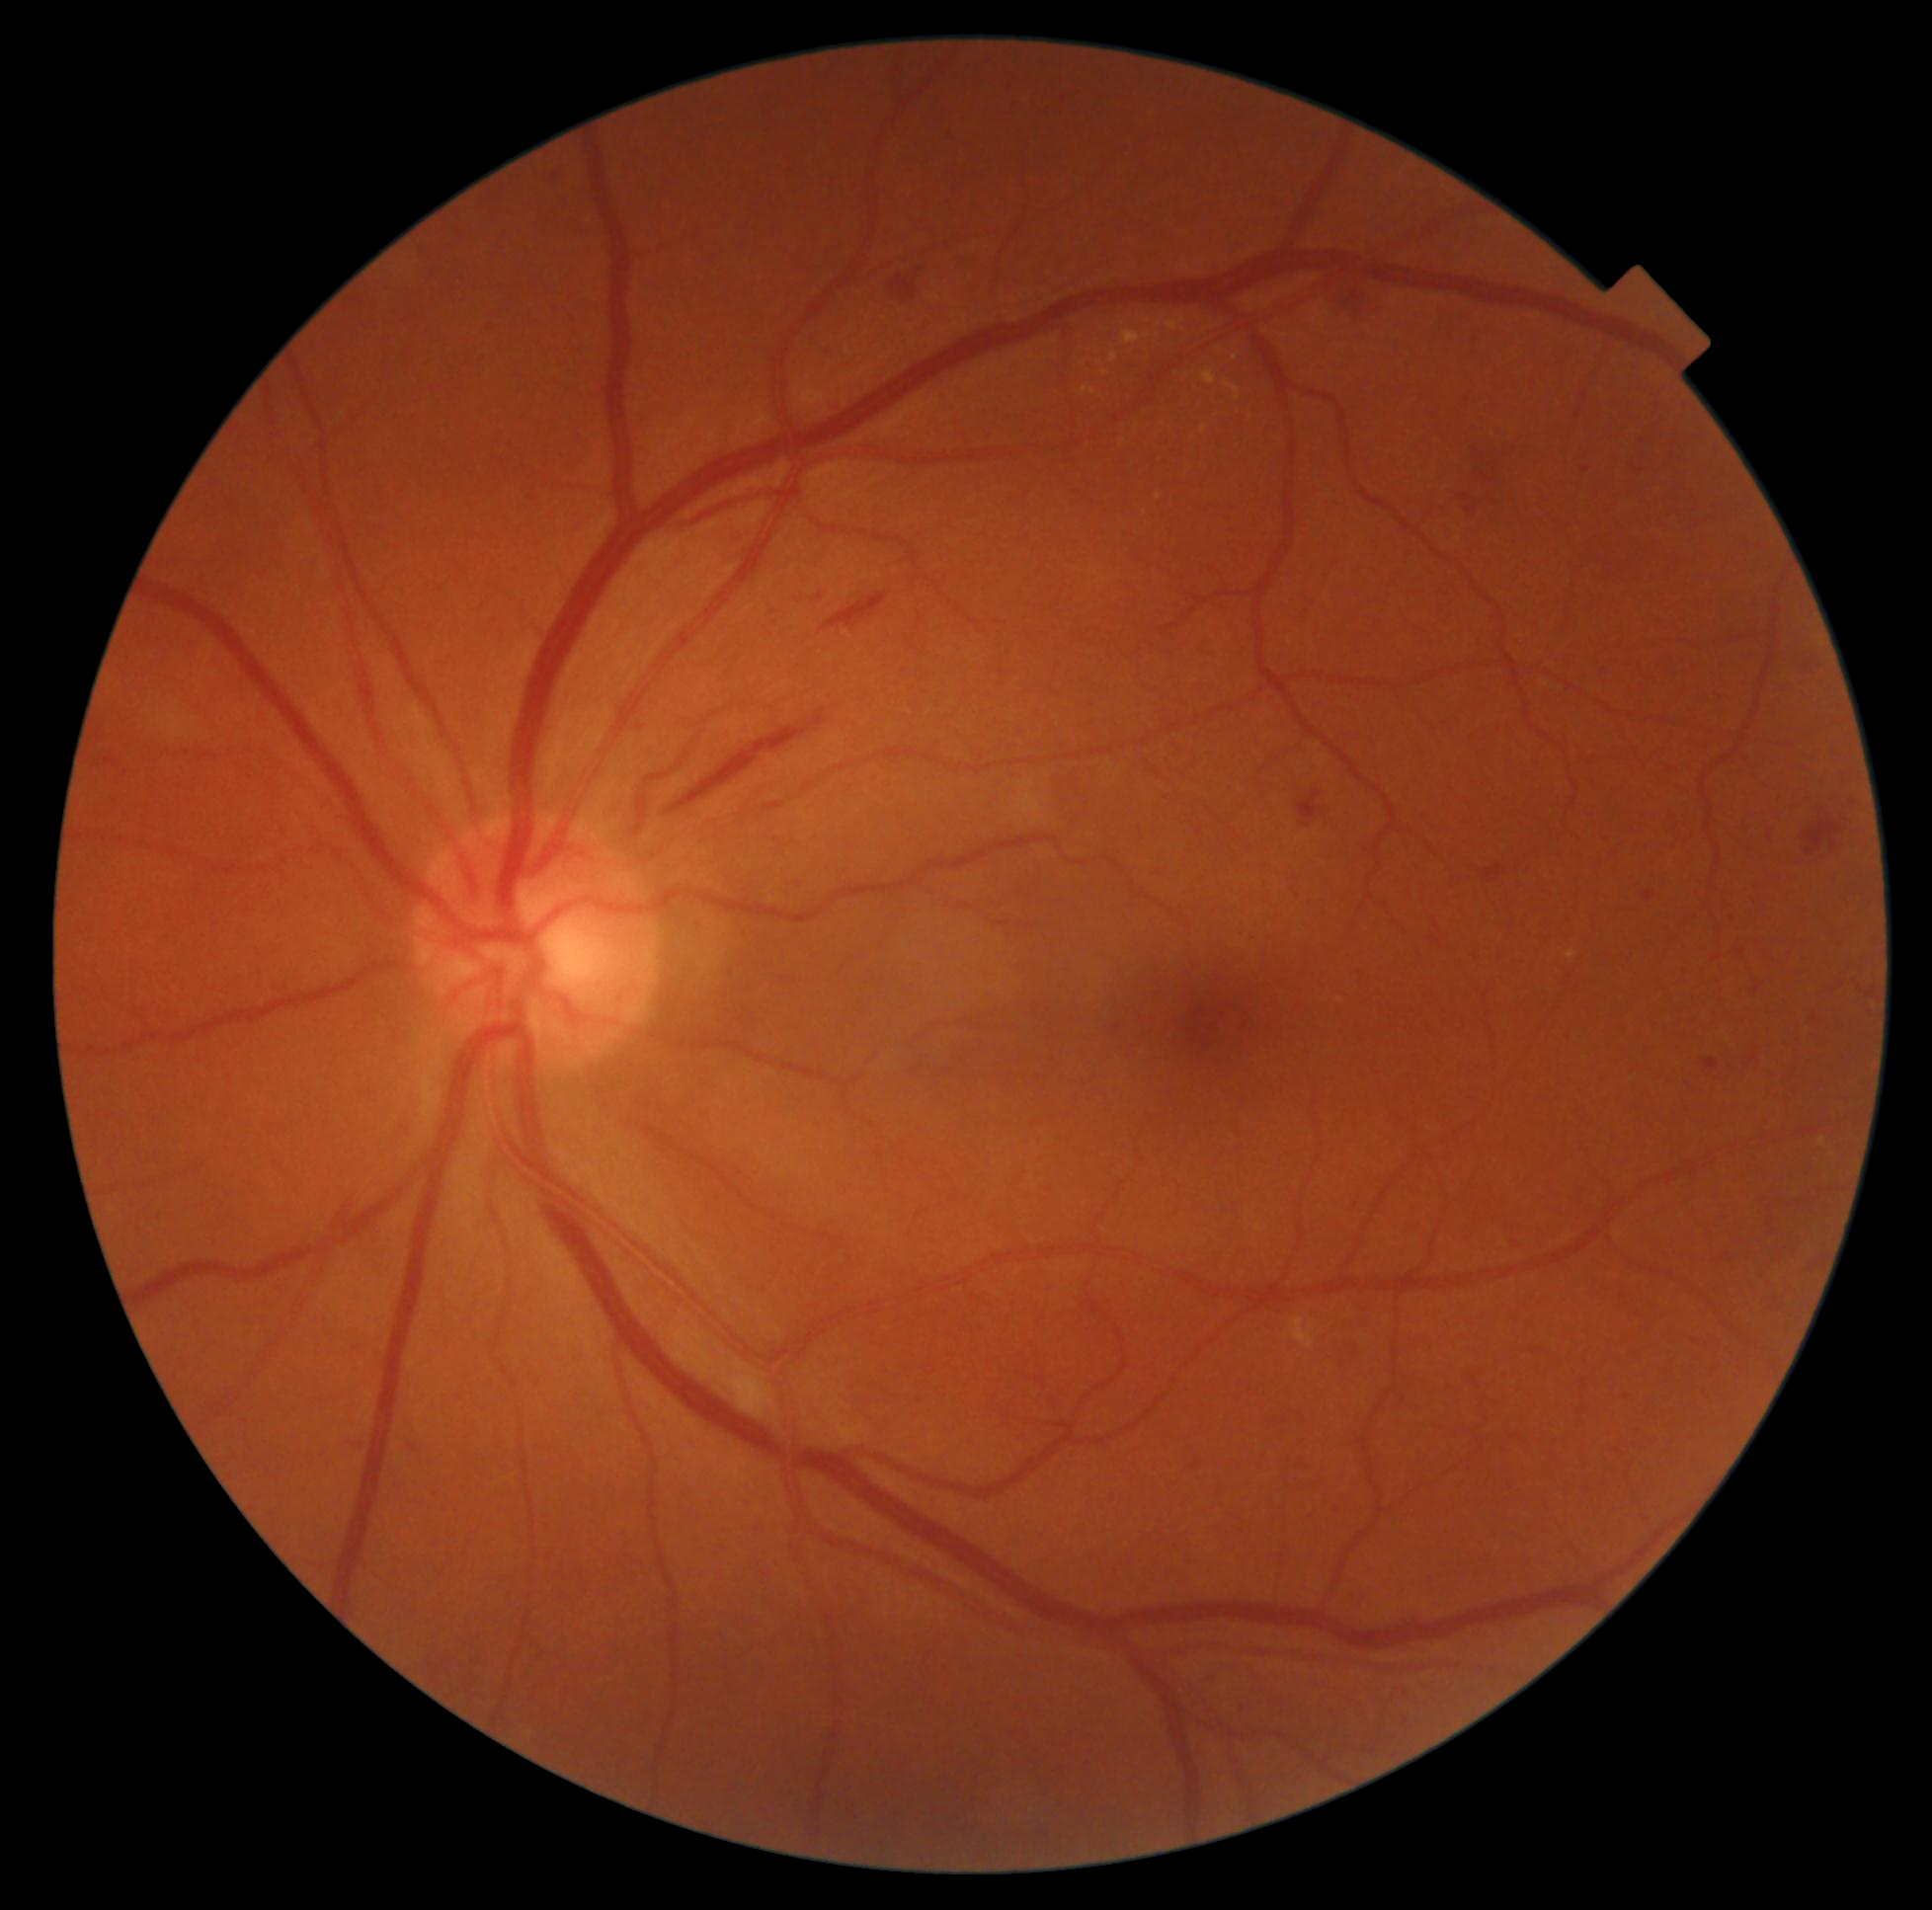
DR: grade 2 (moderate NPDR). EXs (partial list) at (left=1167, top=317, right=1186, bottom=332) | (left=1109, top=352, right=1118, bottom=364) | (left=1122, top=330, right=1153, bottom=346) | (left=1158, top=319, right=1165, bottom=328) | (left=1203, top=369, right=1217, bottom=385) | (left=1201, top=425, right=1208, bottom=434) | (left=1083, top=385, right=1097, bottom=396) | (left=1224, top=380, right=1241, bottom=402). Additional small EXs near (1159,336) | (1099,362) | (1085,363) | (1149,323) | (1251,418) | (1236,357) | (1124,441) | (1104,373). MAs (partial list) at (left=1703, top=1058, right=1720, bottom=1073) | (left=1115, top=1025, right=1122, bottom=1035) | (left=1644, top=893, right=1654, bottom=902) | (left=1811, top=1016, right=1819, bottom=1026) | (left=1432, top=937, right=1439, bottom=945). Additional small MAs near (1585,470) | (413,1448) | (1743,952) | (362,1446) | (1733,919). SEs present at (left=735, top=1370, right=770, bottom=1414) | (left=1016, top=792, right=1043, bottom=825) | (left=1020, top=782, right=1030, bottom=791). Additional small SEs near (1018,819). HEs present at (left=729, top=525, right=740, bottom=539) | (left=1468, top=501, right=1477, bottom=517) | (left=1483, top=866, right=1505, bottom=882) | (left=1353, top=292, right=1360, bottom=301) | (left=821, top=594, right=889, bottom=635) | (left=1481, top=473, right=1489, bottom=481) | (left=1804, top=658, right=1817, bottom=675) | (left=1802, top=807, right=1845, bottom=857) | (left=1298, top=791, right=1325, bottom=827) | (left=683, top=710, right=826, bottom=807) | (left=816, top=345, right=832, bottom=357) | (left=889, top=277, right=916, bottom=301). Additional small HEs near (923,269) | (1466,498).